1960x1897:
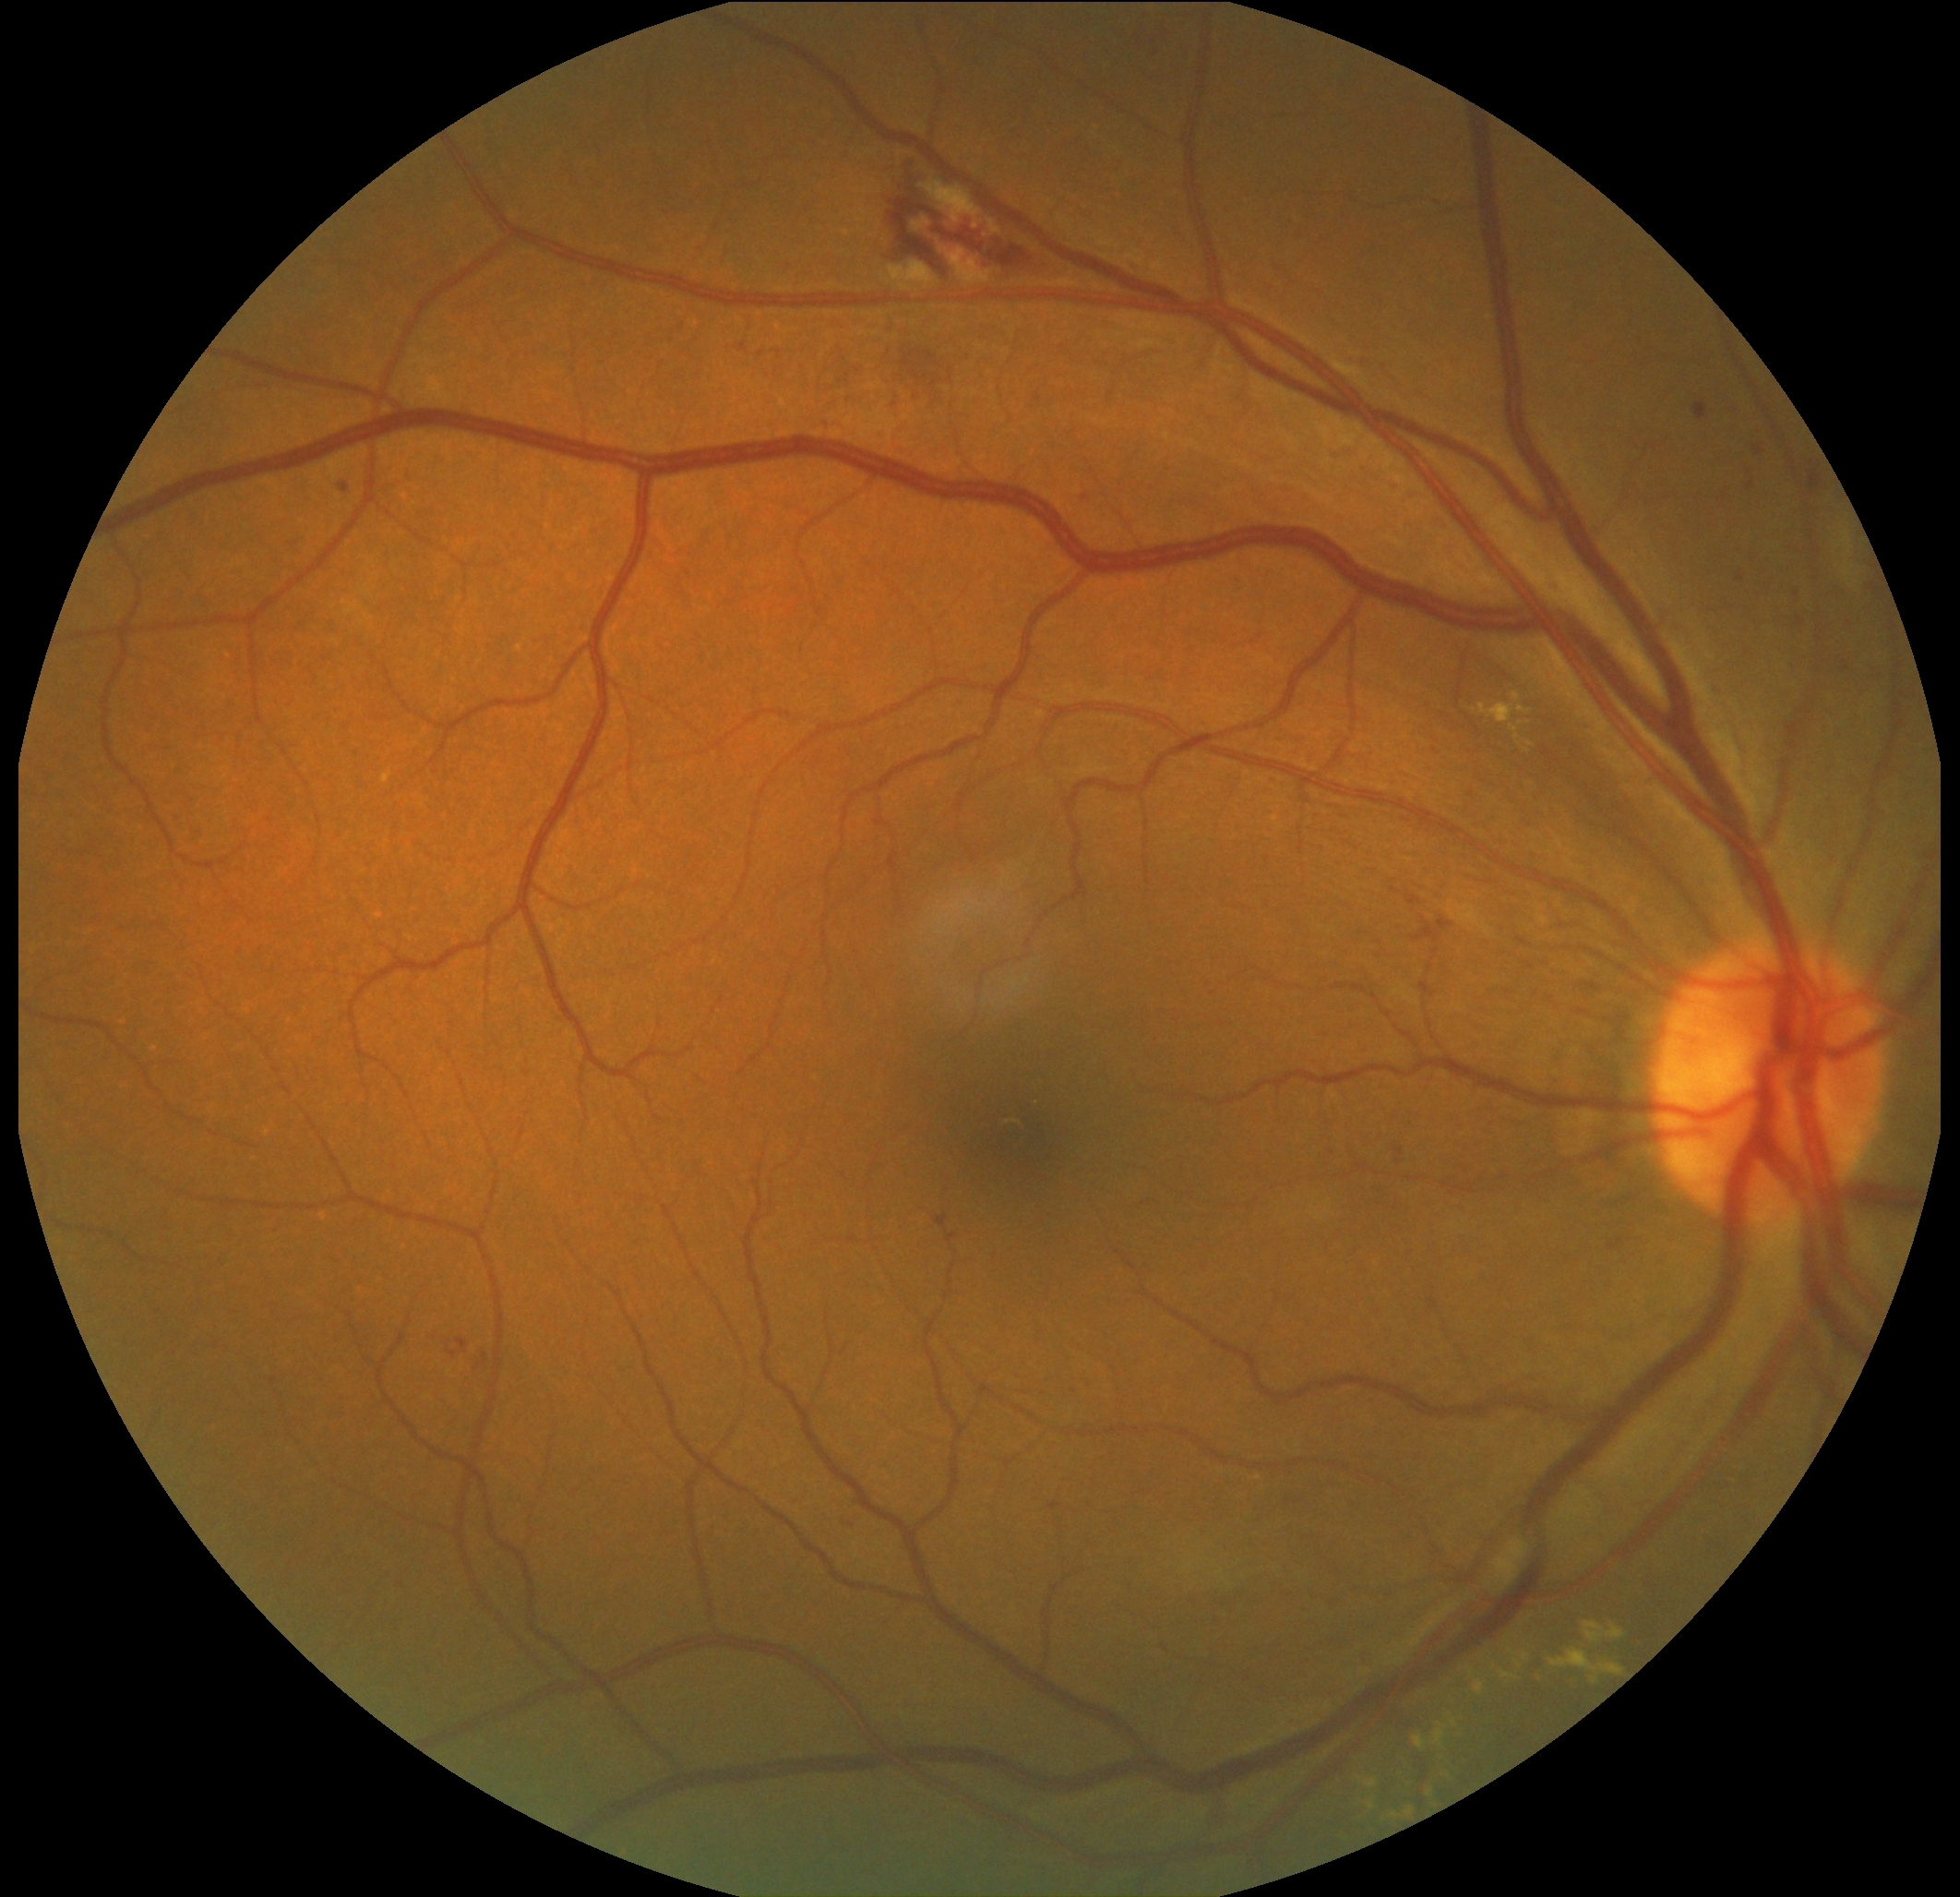

DR stage: moderate non-proliferative diabetic retinopathy (grade 2).